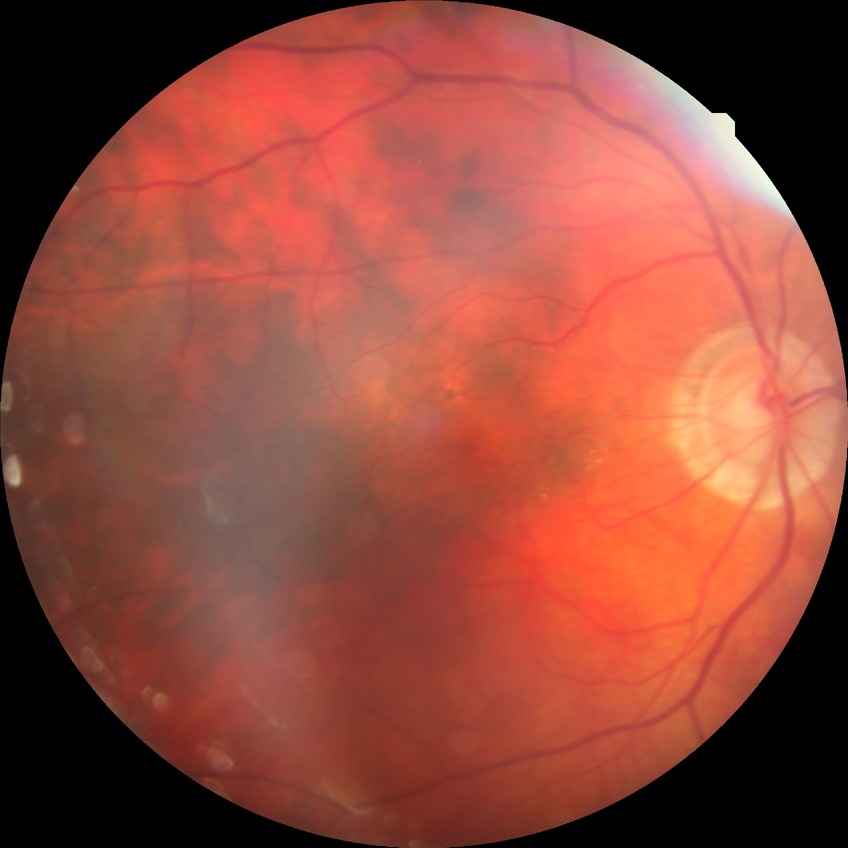 Diabetic retinopathy (DR) is no diabetic retinopathy (NDR).